Pediatric retinal photograph (wide-field).
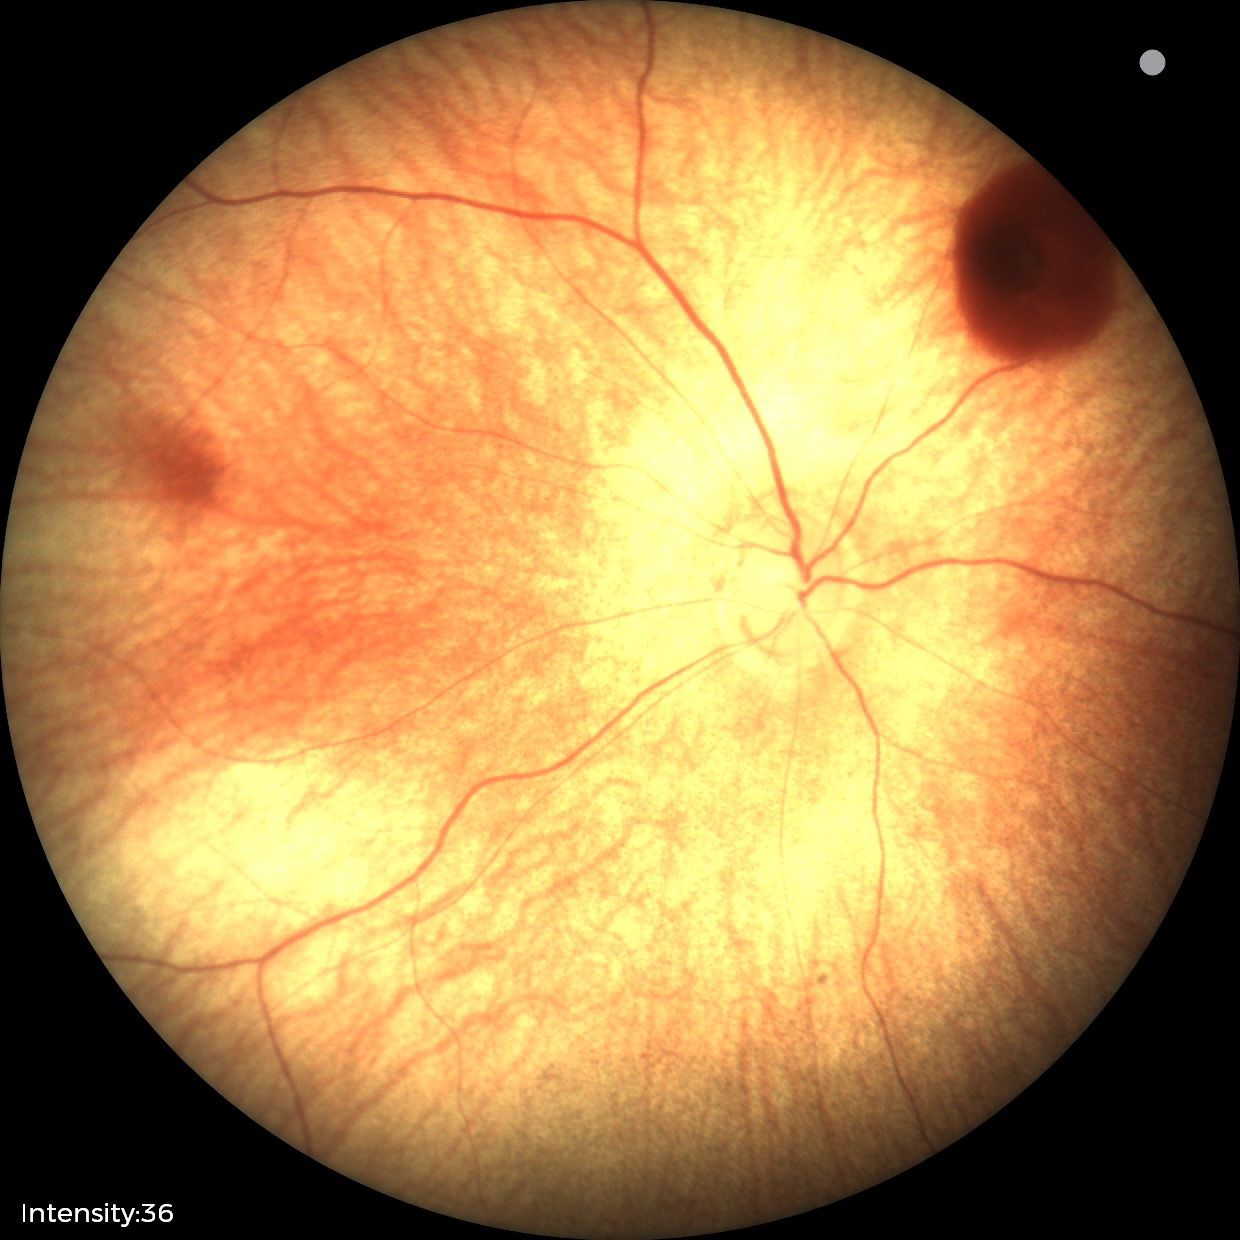 Screening series with retinal hemorrhages.